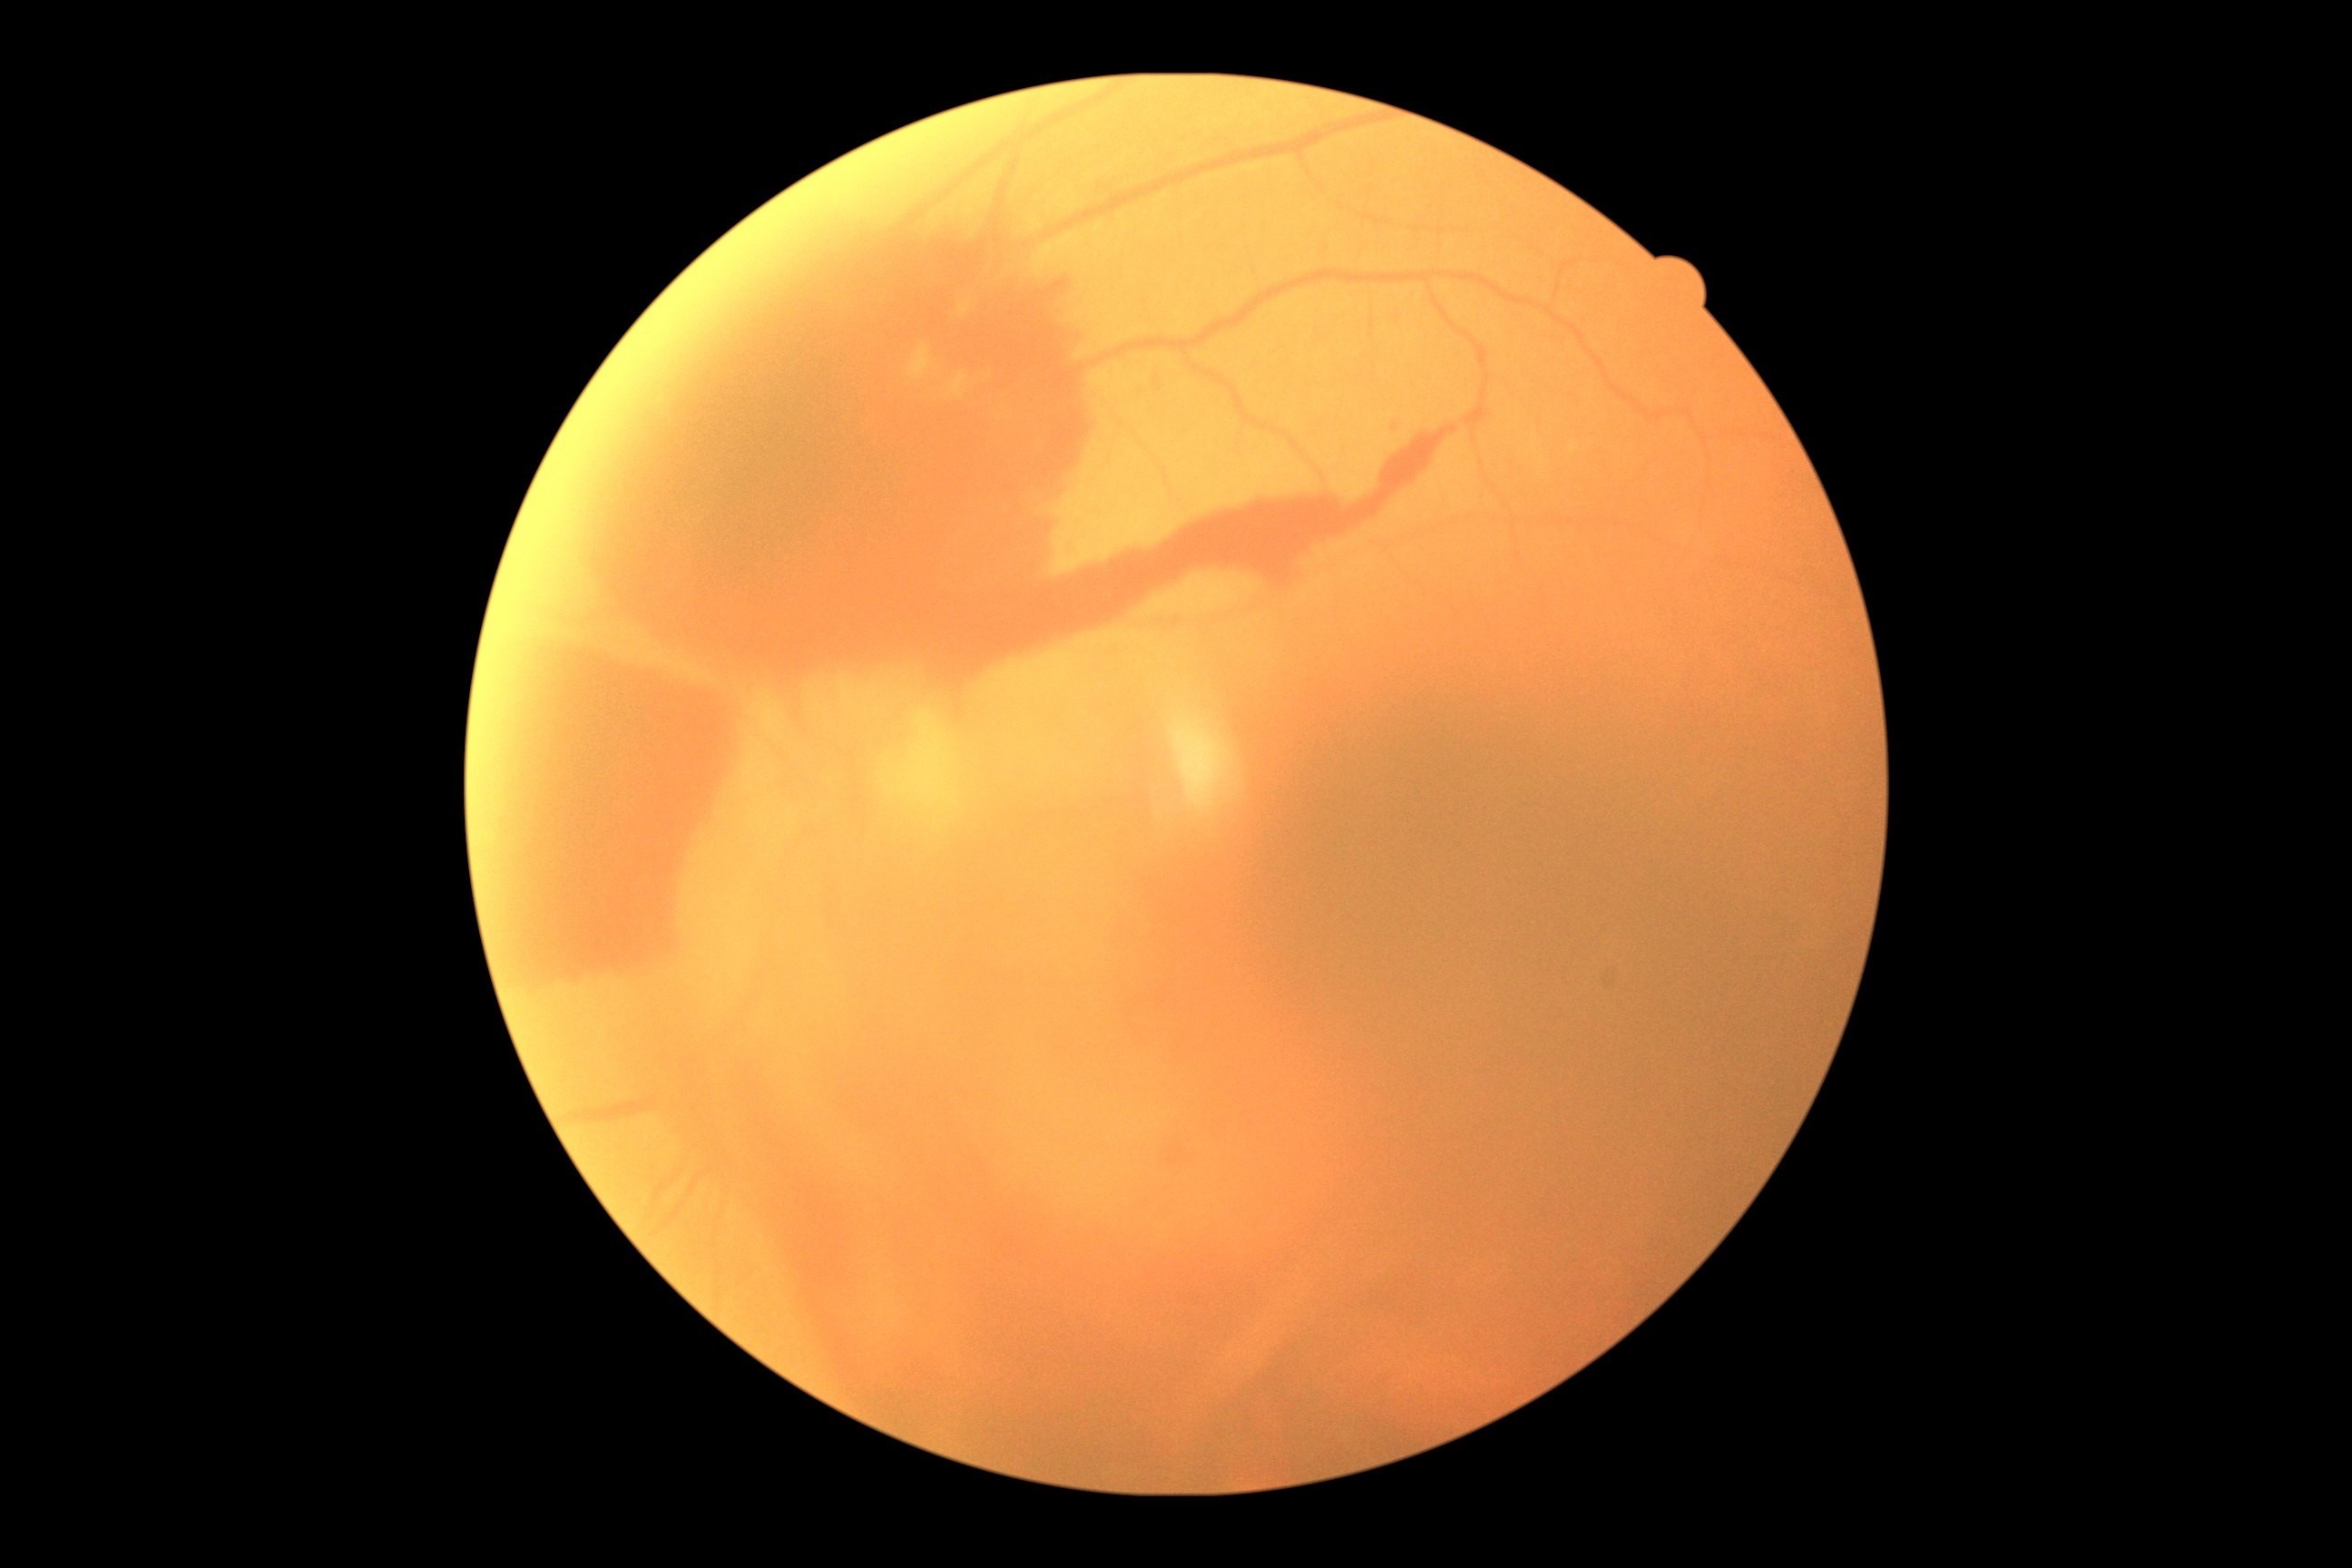

Findings:
- DR stage: grade 4 (PDR)
- DR class: proliferative diabetic retinopathy